1924 by 1556 pixels, 200° field of view: 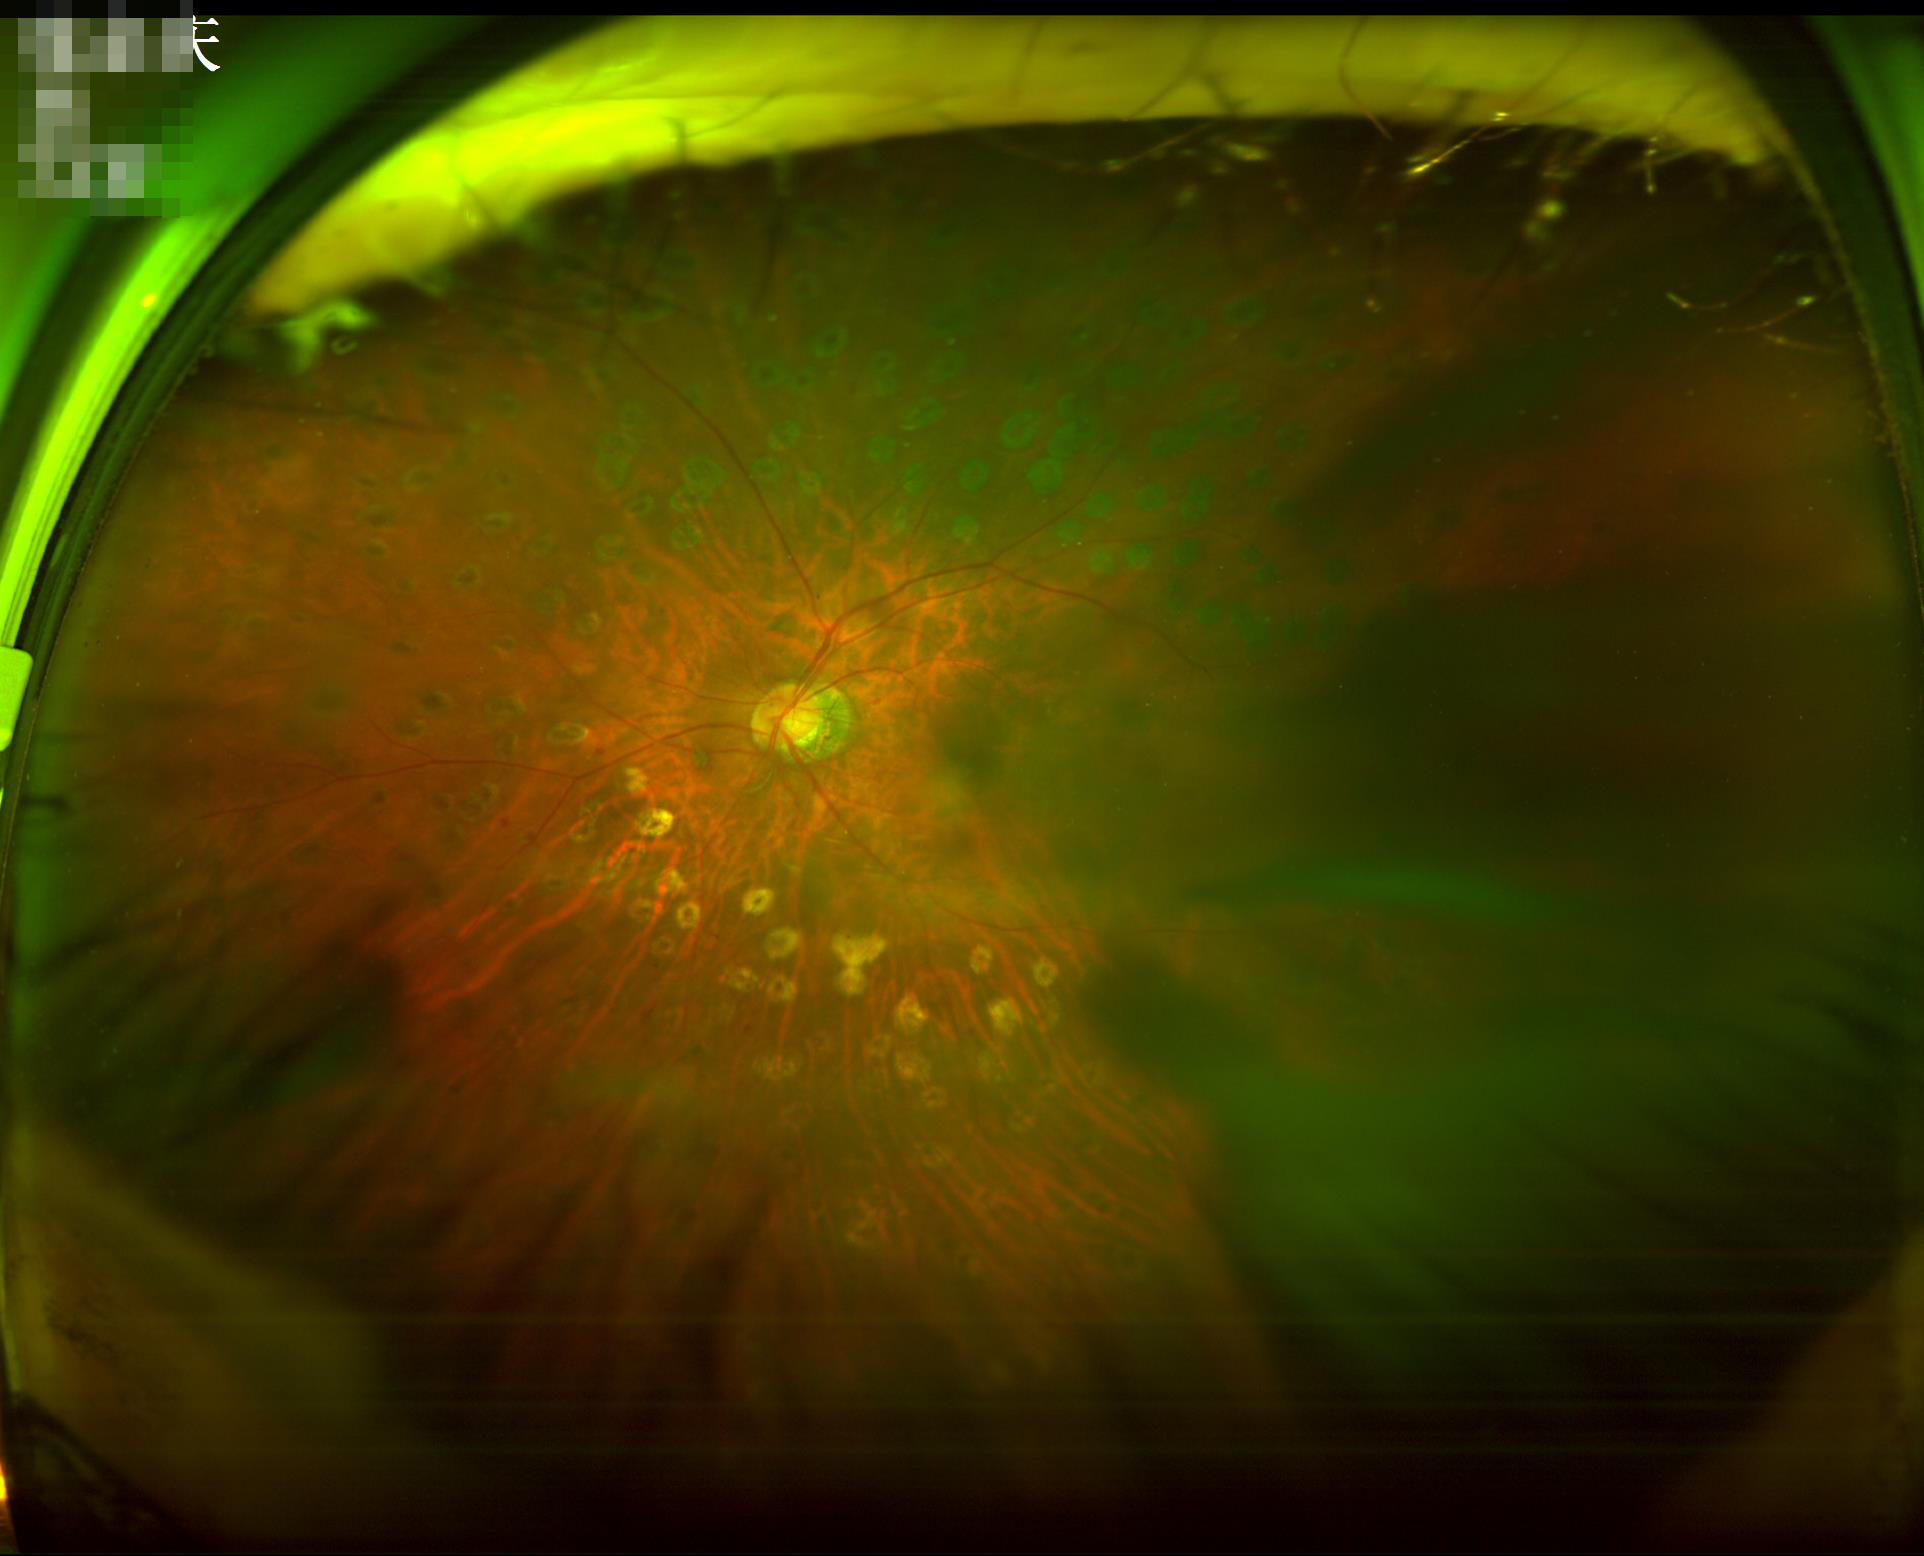 Contrast is good. Illumination and color are suboptimal. Noticeable blur in the optic disc, vessels, or background. Overall image quality is poor.